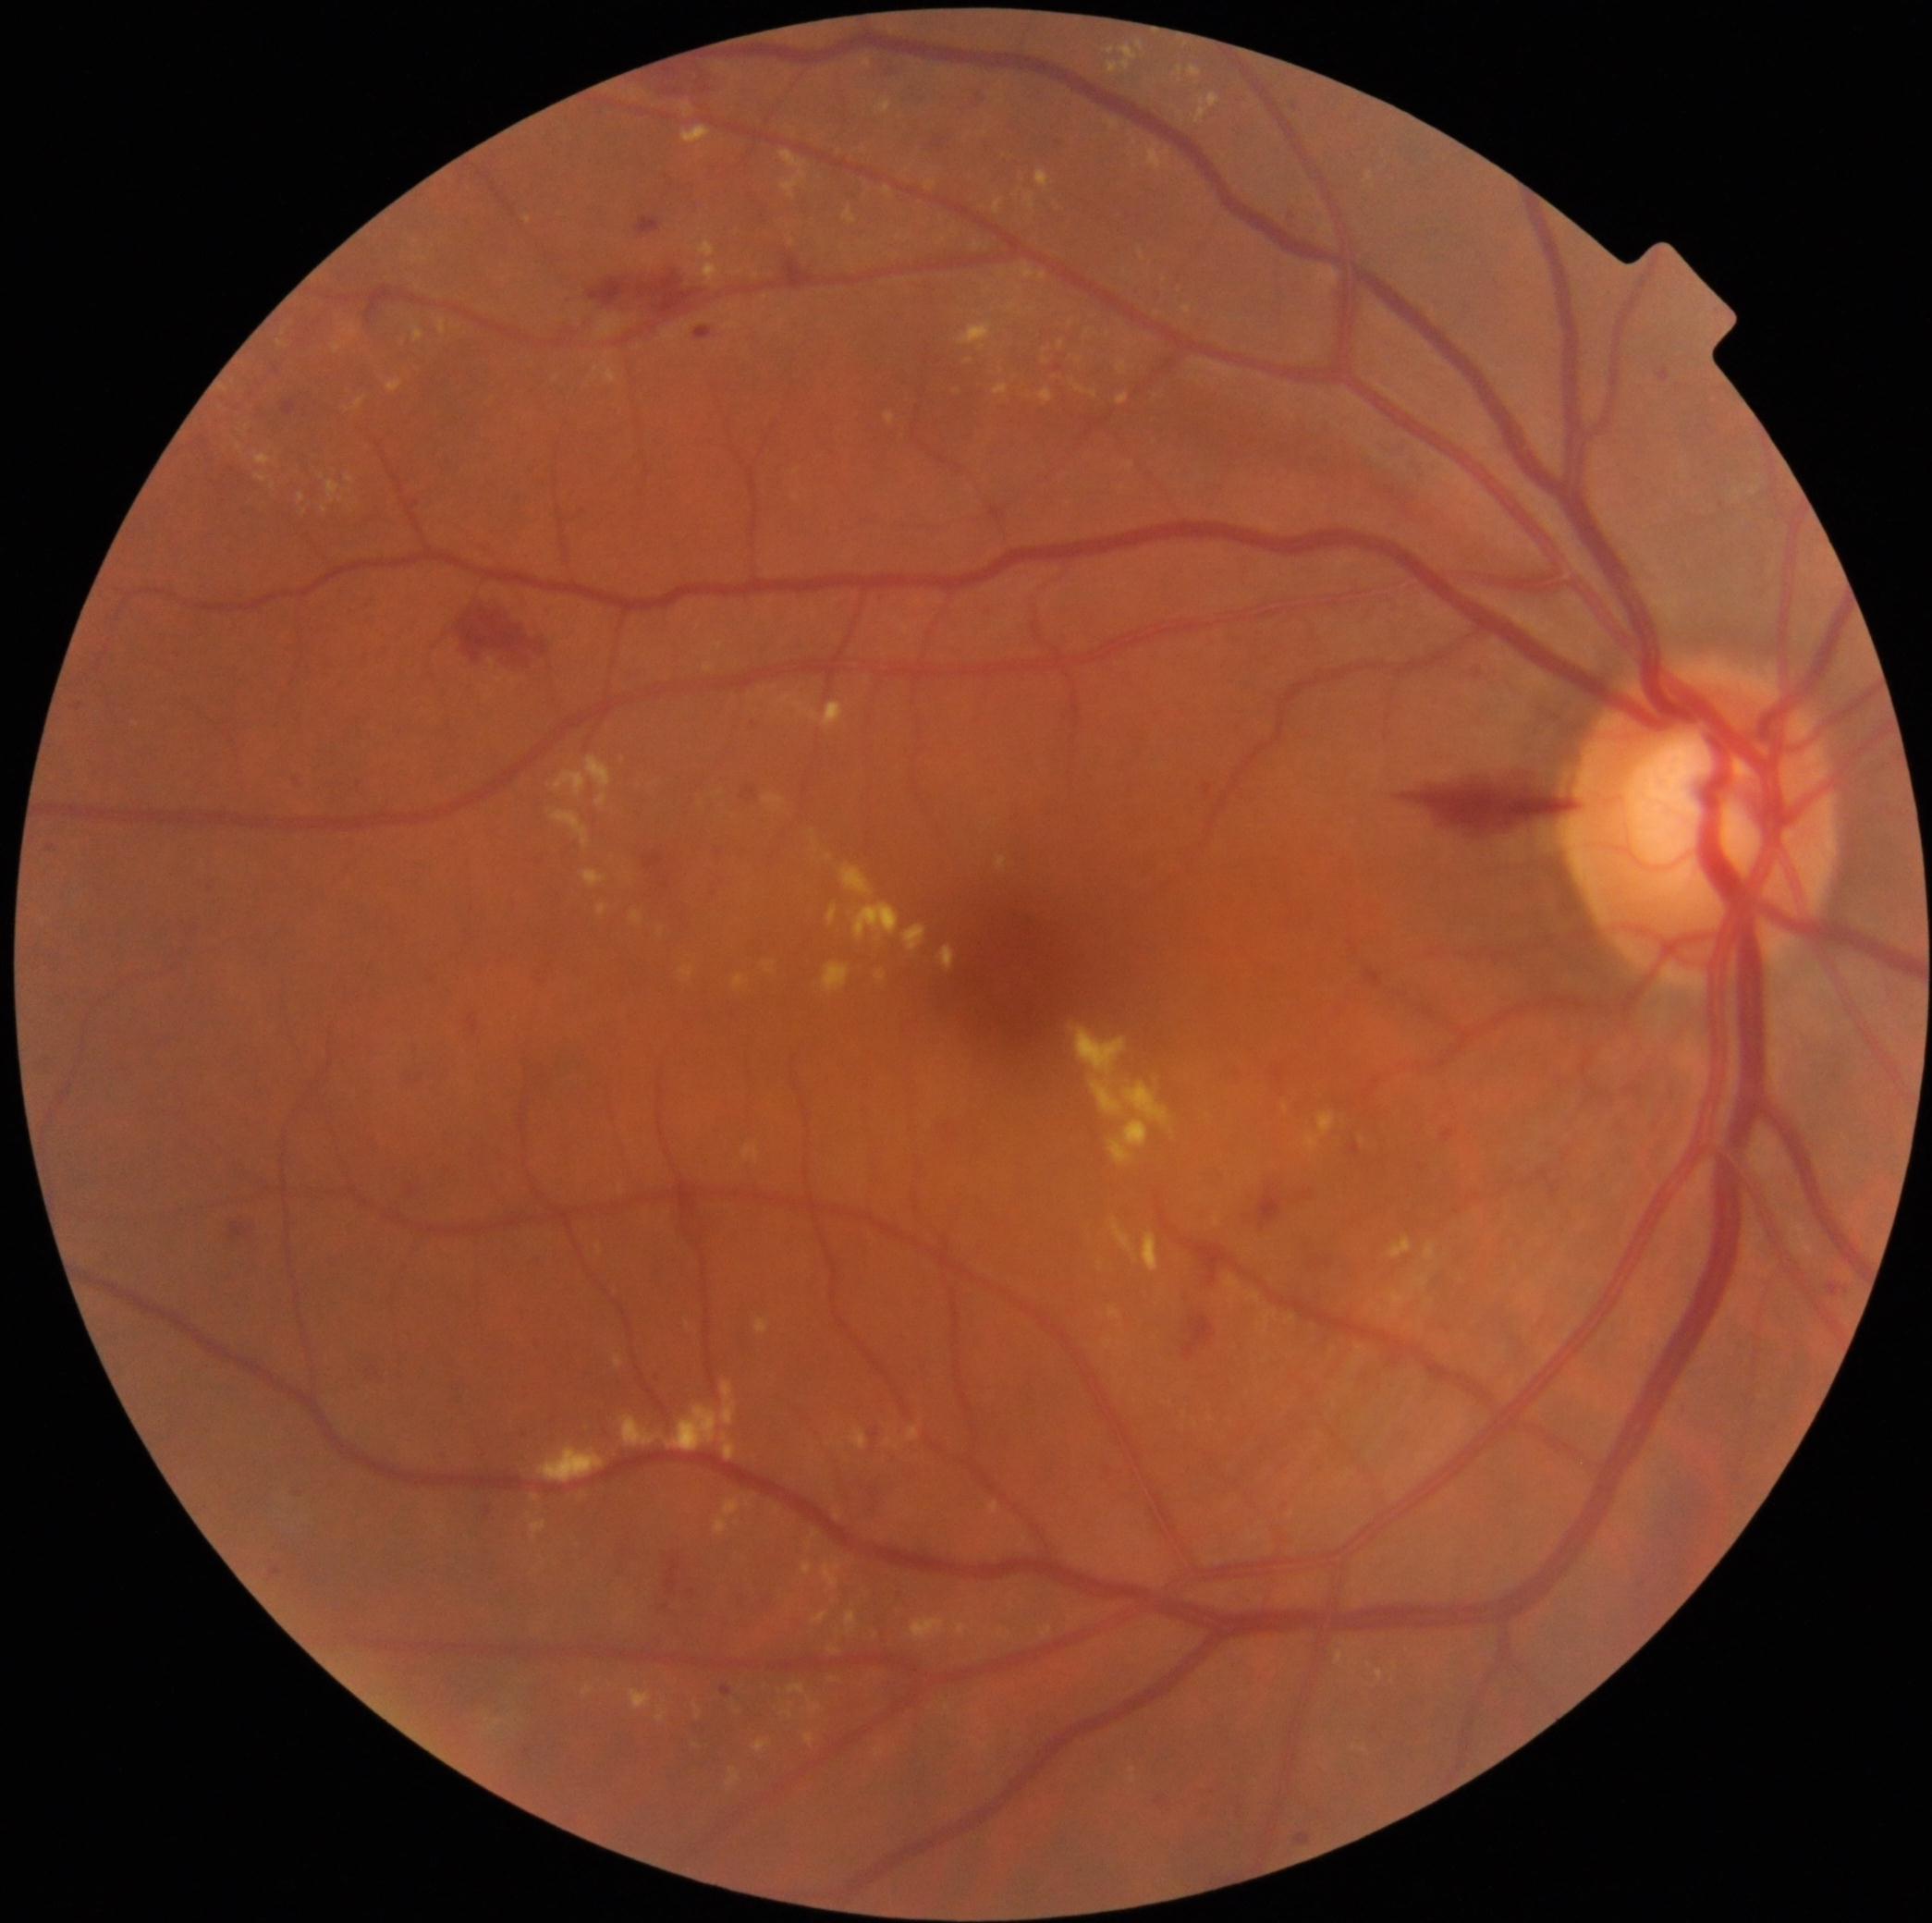

Diabetic retinopathy (DR) is grade 2 (moderate NPDR)
A subset of detected lesions:
hard exudates (EXs) (subset): 733, 974, 748, 989; 1085, 328, 1094, 337; 812, 1612, 828, 1623; 1118, 361, 1127, 375; 386, 379, 403, 394; 625, 1611, 636, 1620; 994, 199, 1003, 216; 722, 1433, 737, 1461; 904, 925, 926, 951; 1107, 45, 1138, 74; 619, 1185, 623, 1194; 1215, 1216, 1220, 1227; 621, 1415, 664, 1448; 1059, 341, 1065, 349
EXs (small, approximate centers) near (834; 1680); (749; 1504); (1365; 1750); (844; 248); (1381; 1311)